Modified Davis classification — 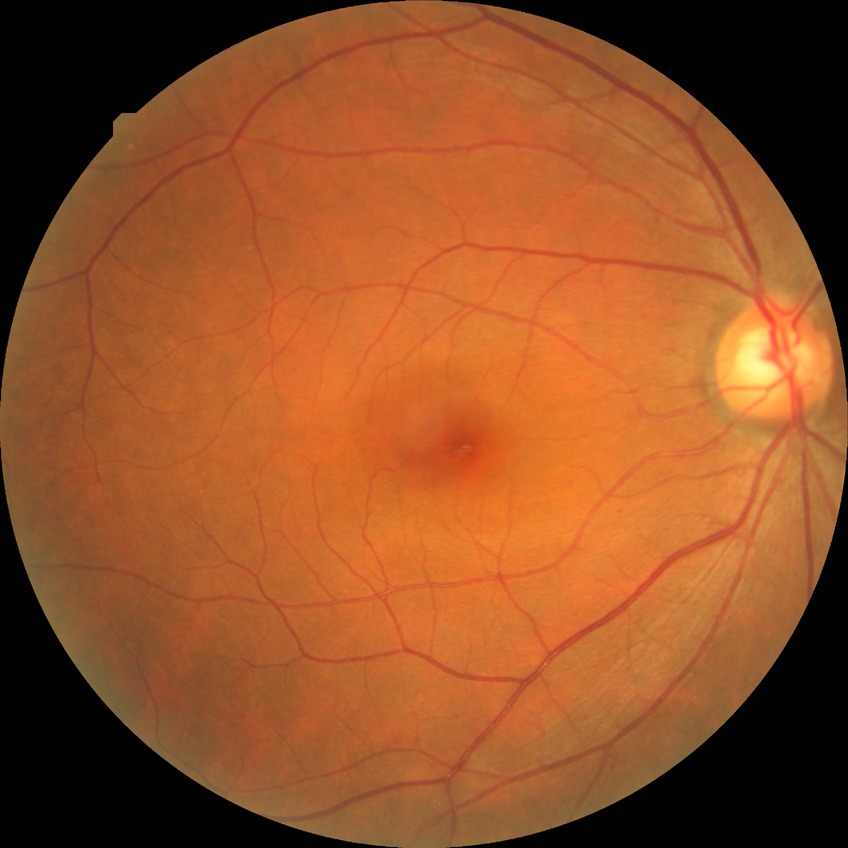

Diabetic retinopathy severity is simple diabetic retinopathy.